Topcon TRC-50DX. FOV: 50 degrees. 2228x1652px — 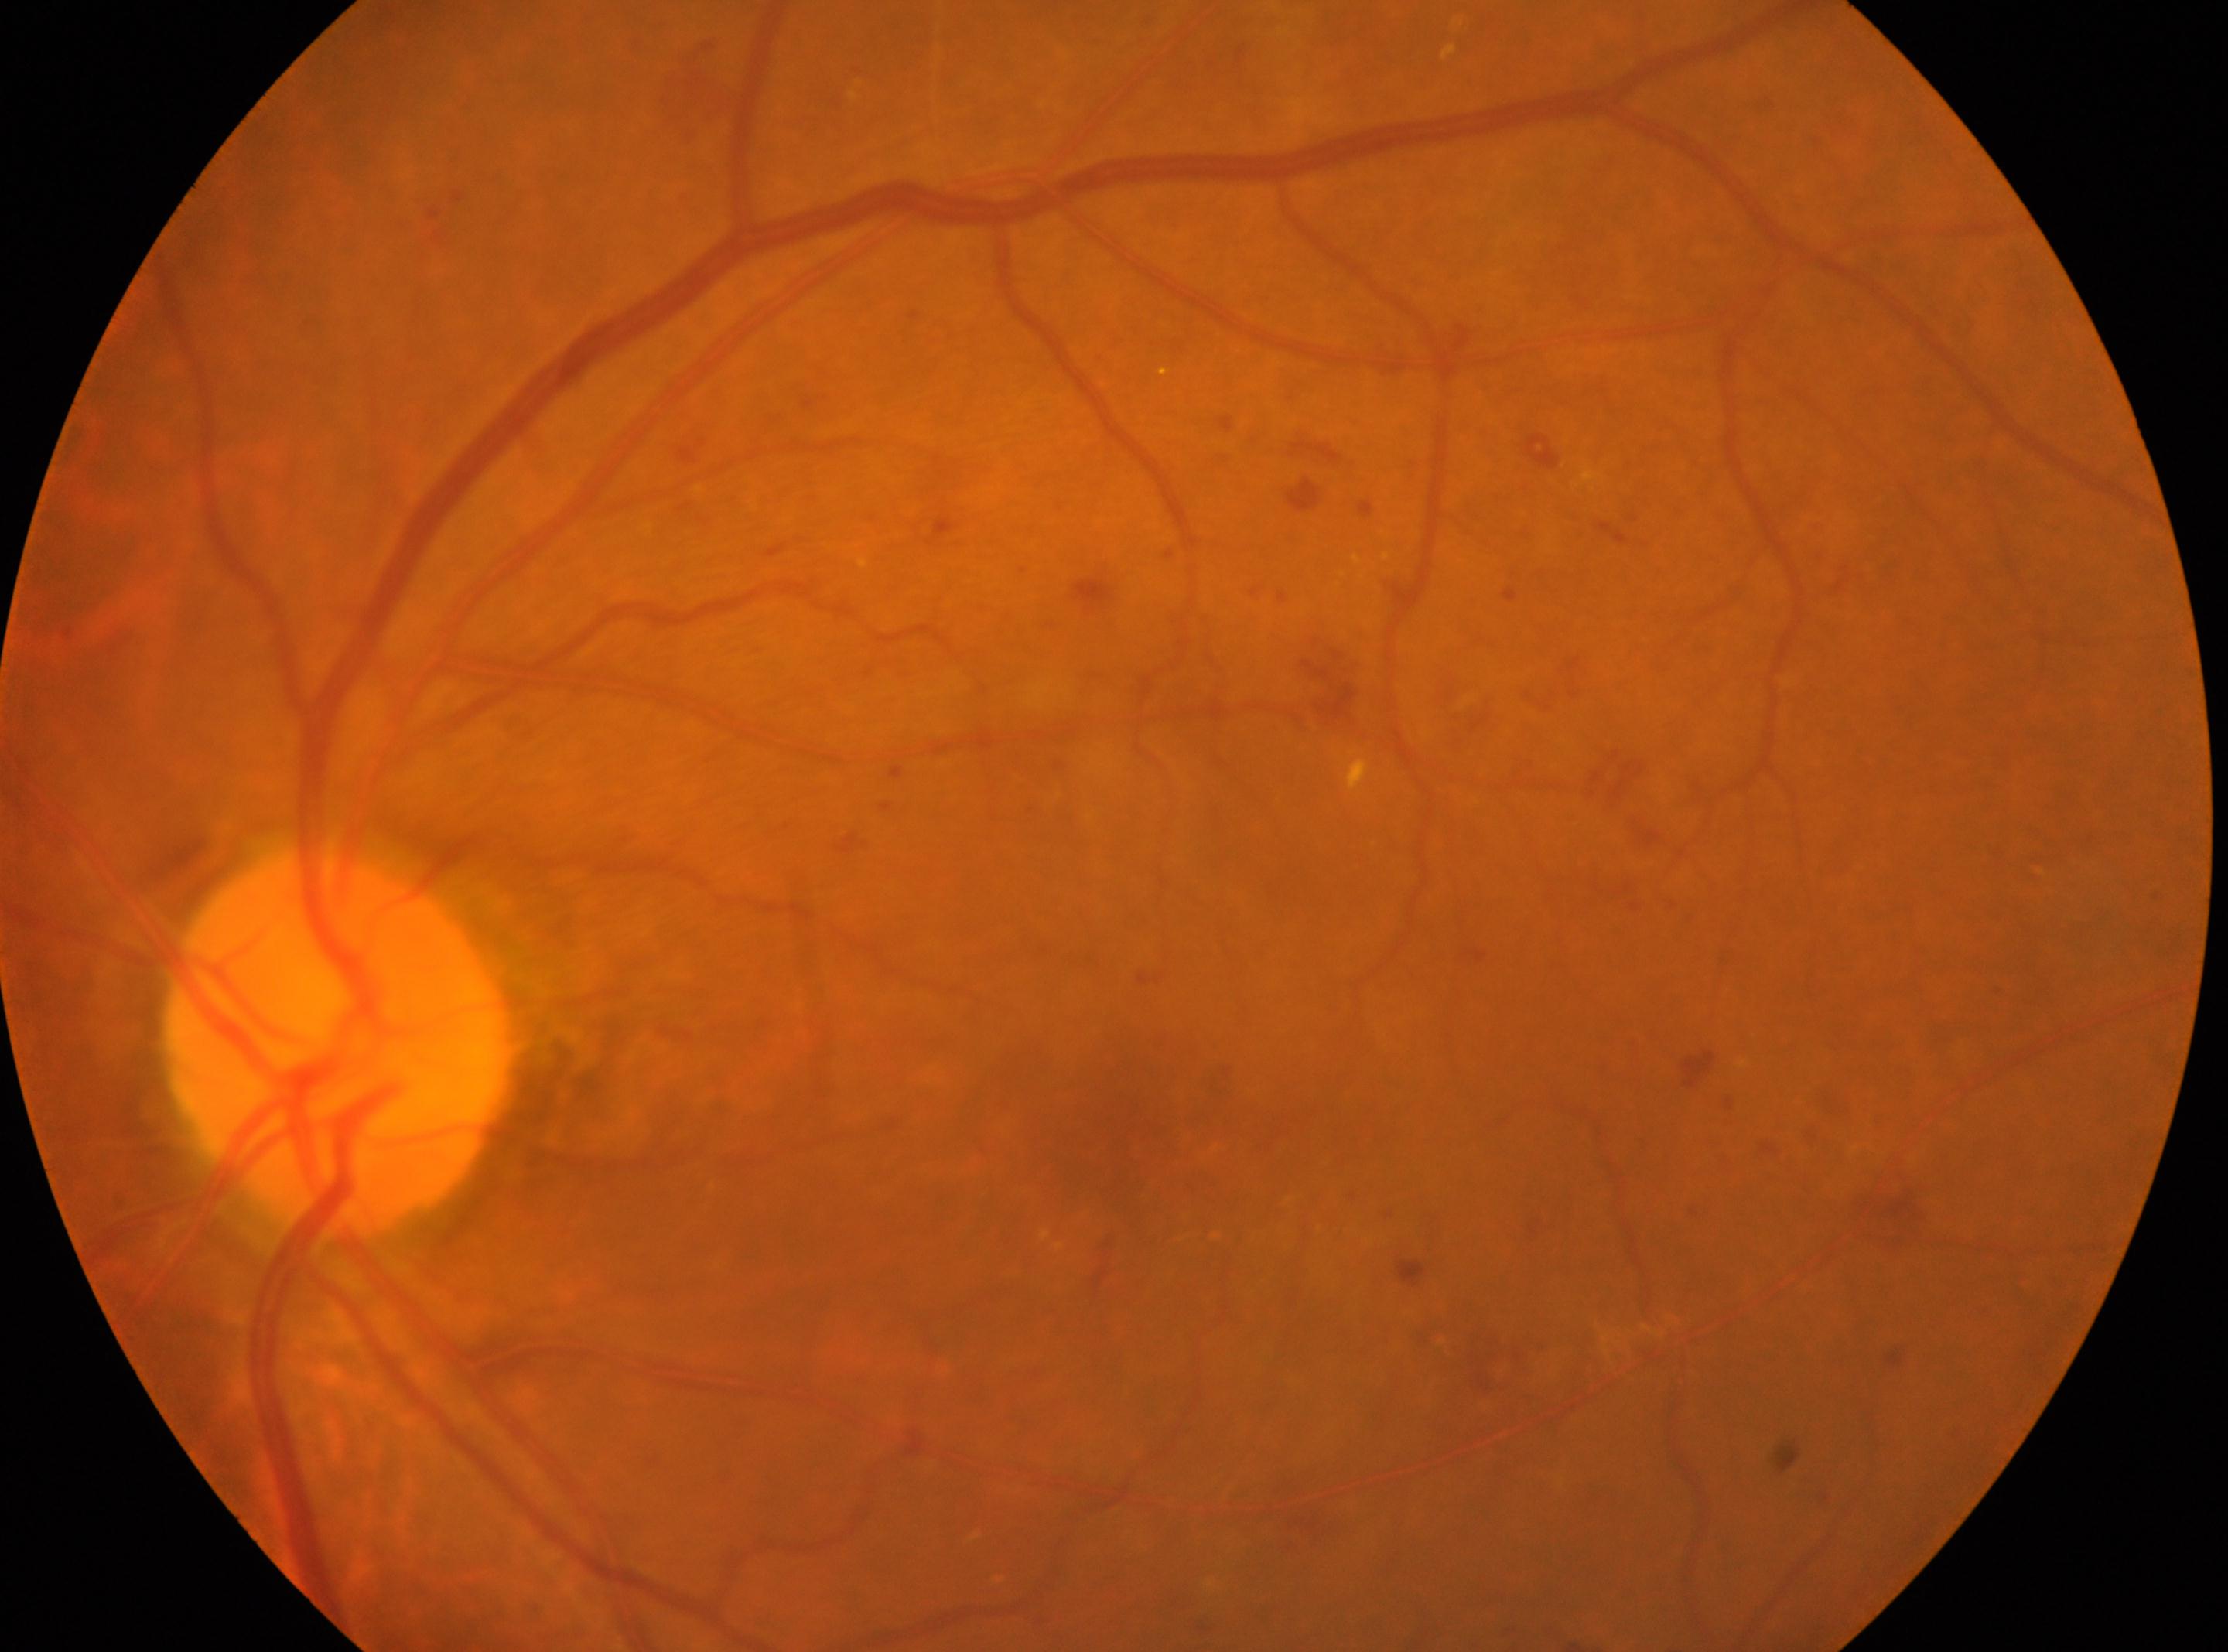

Optic nerve head located at 339, 1041.
Eye: OS.
Diabetic retinopathy grade: 2.
Foveal center located at 1112, 1143.